Color fundus photograph, 45° field of view.
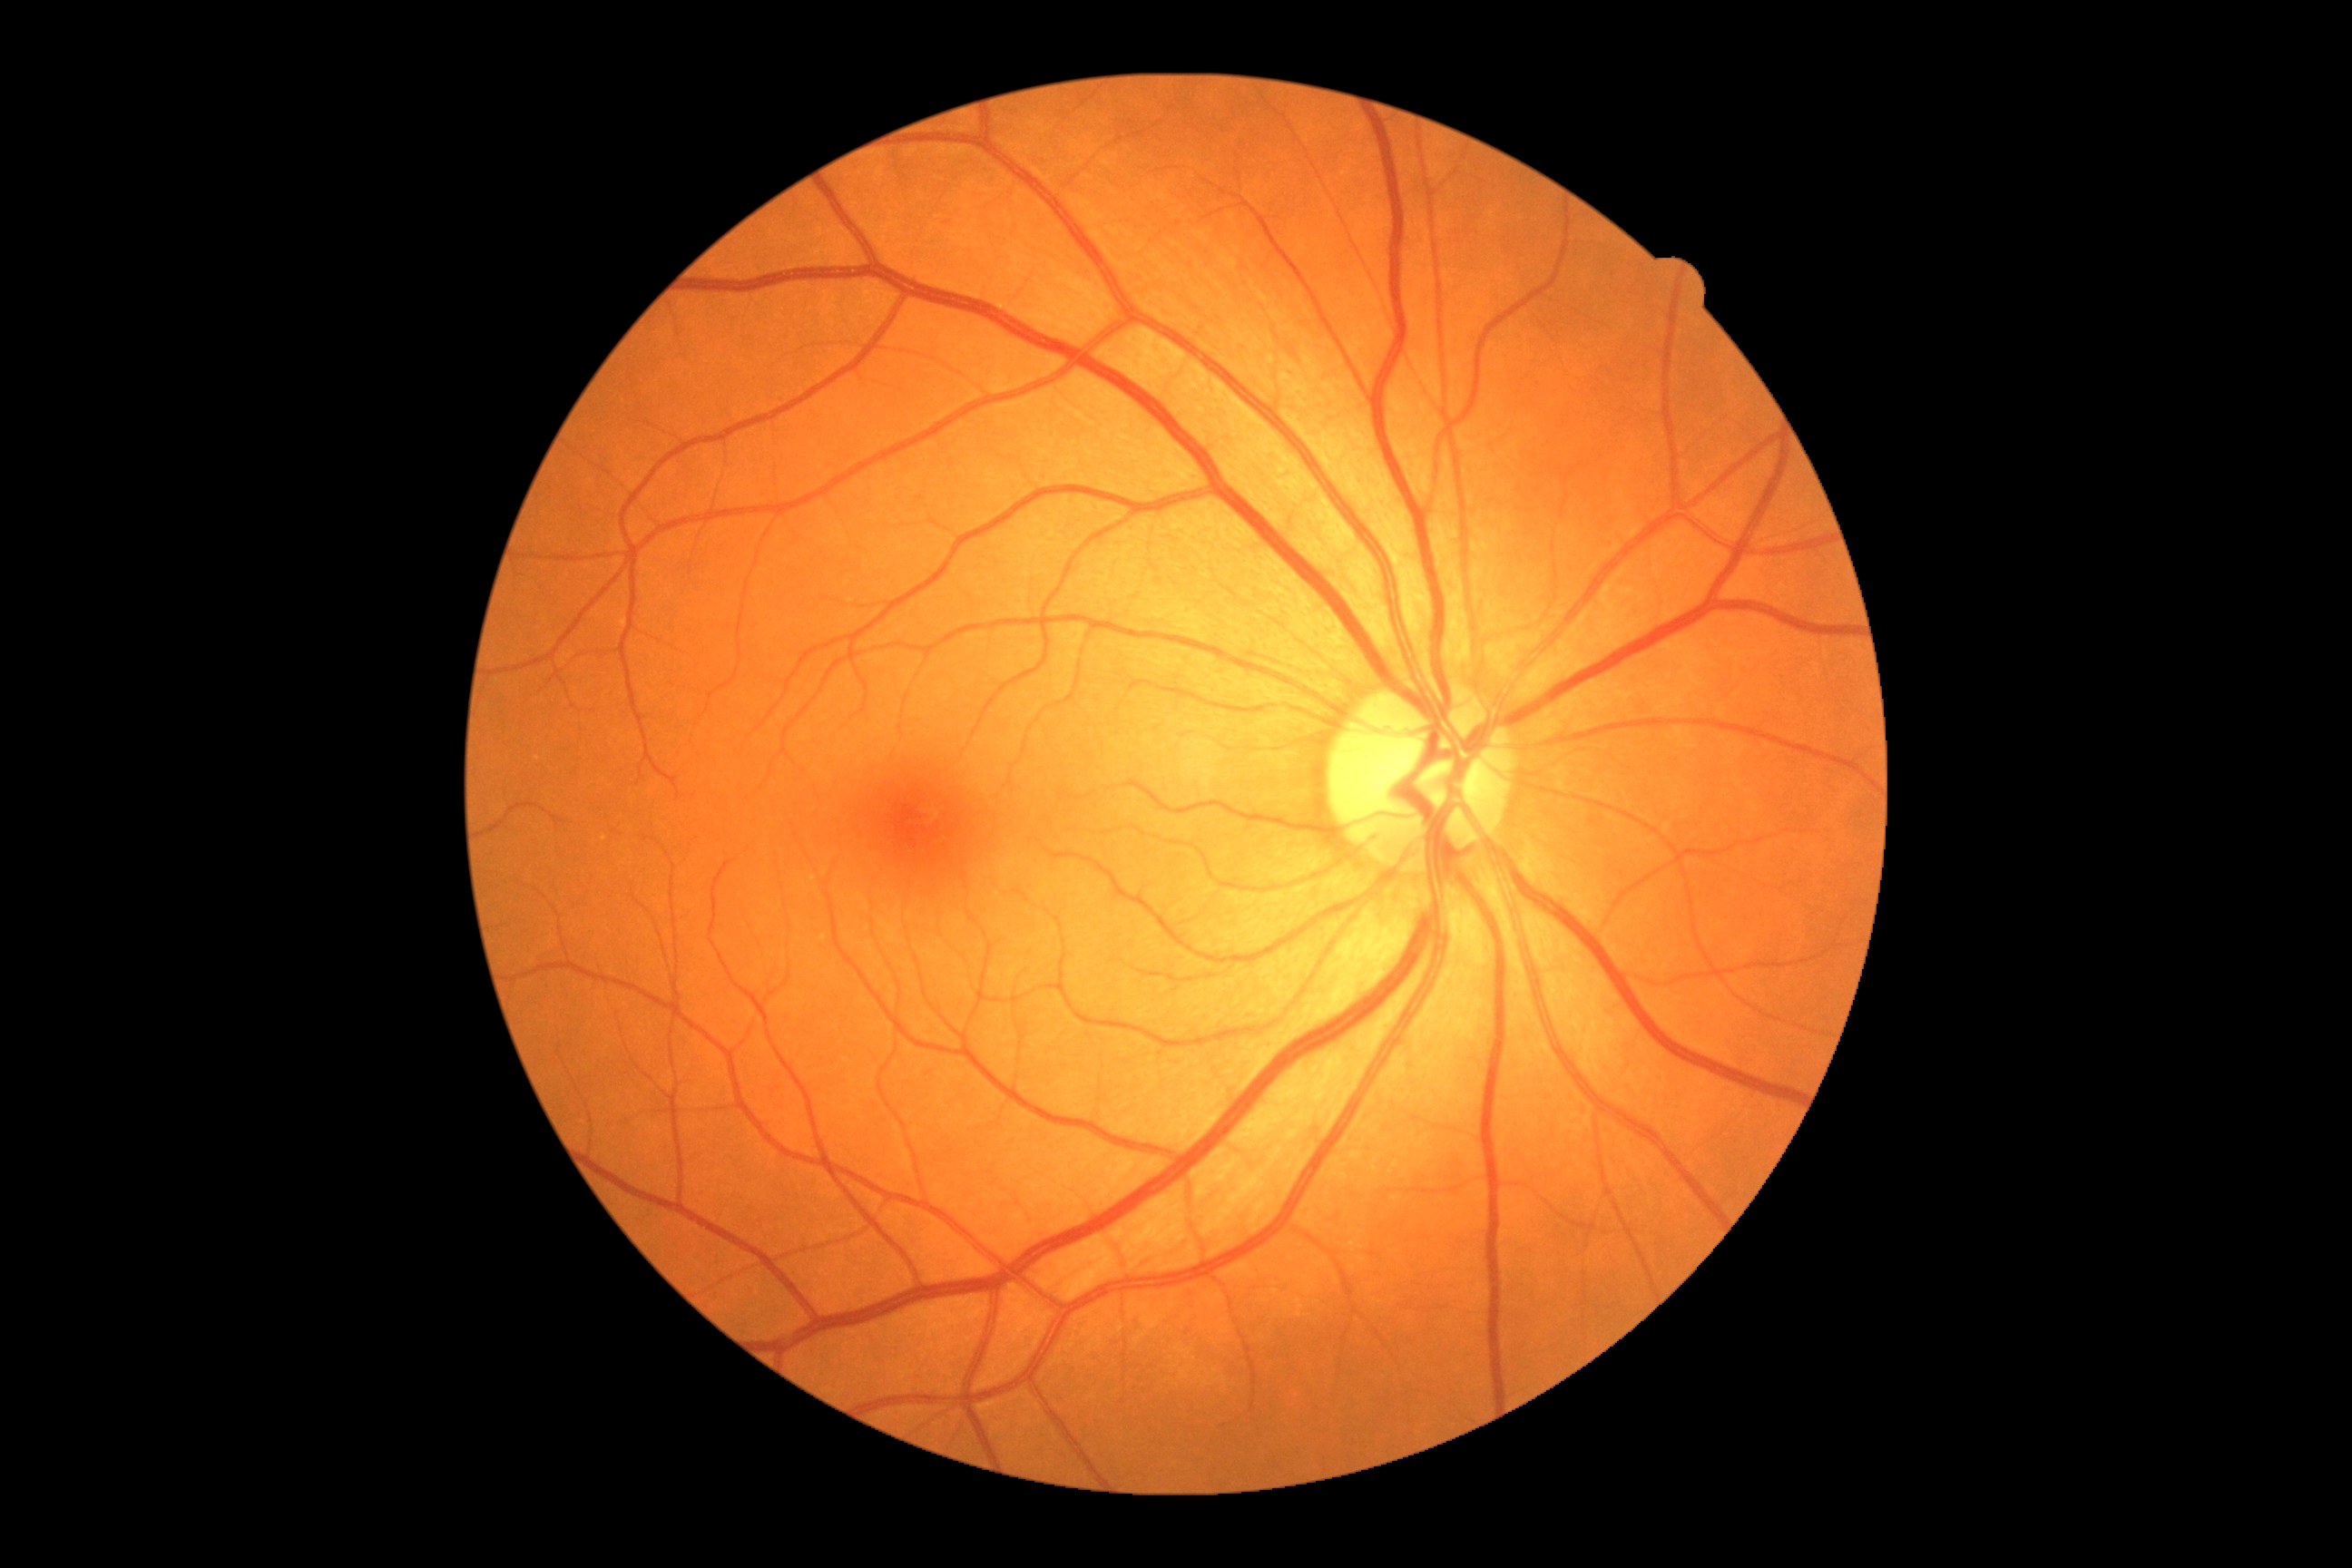 retinopathy = no apparent retinopathy (grade 0); DR impression = no apparent DR.